Davis DR grading.
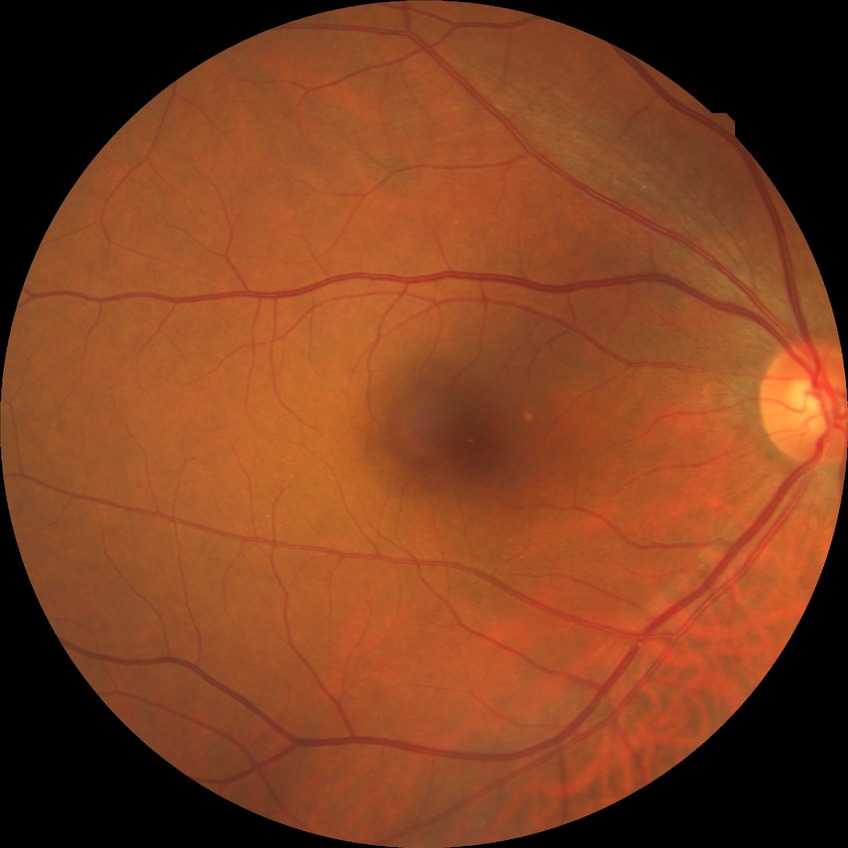

diabetic retinopathy (DR)@no diabetic retinopathy (NDR).